FOV: 45 degrees. Color fundus photograph. 1932x1910 — 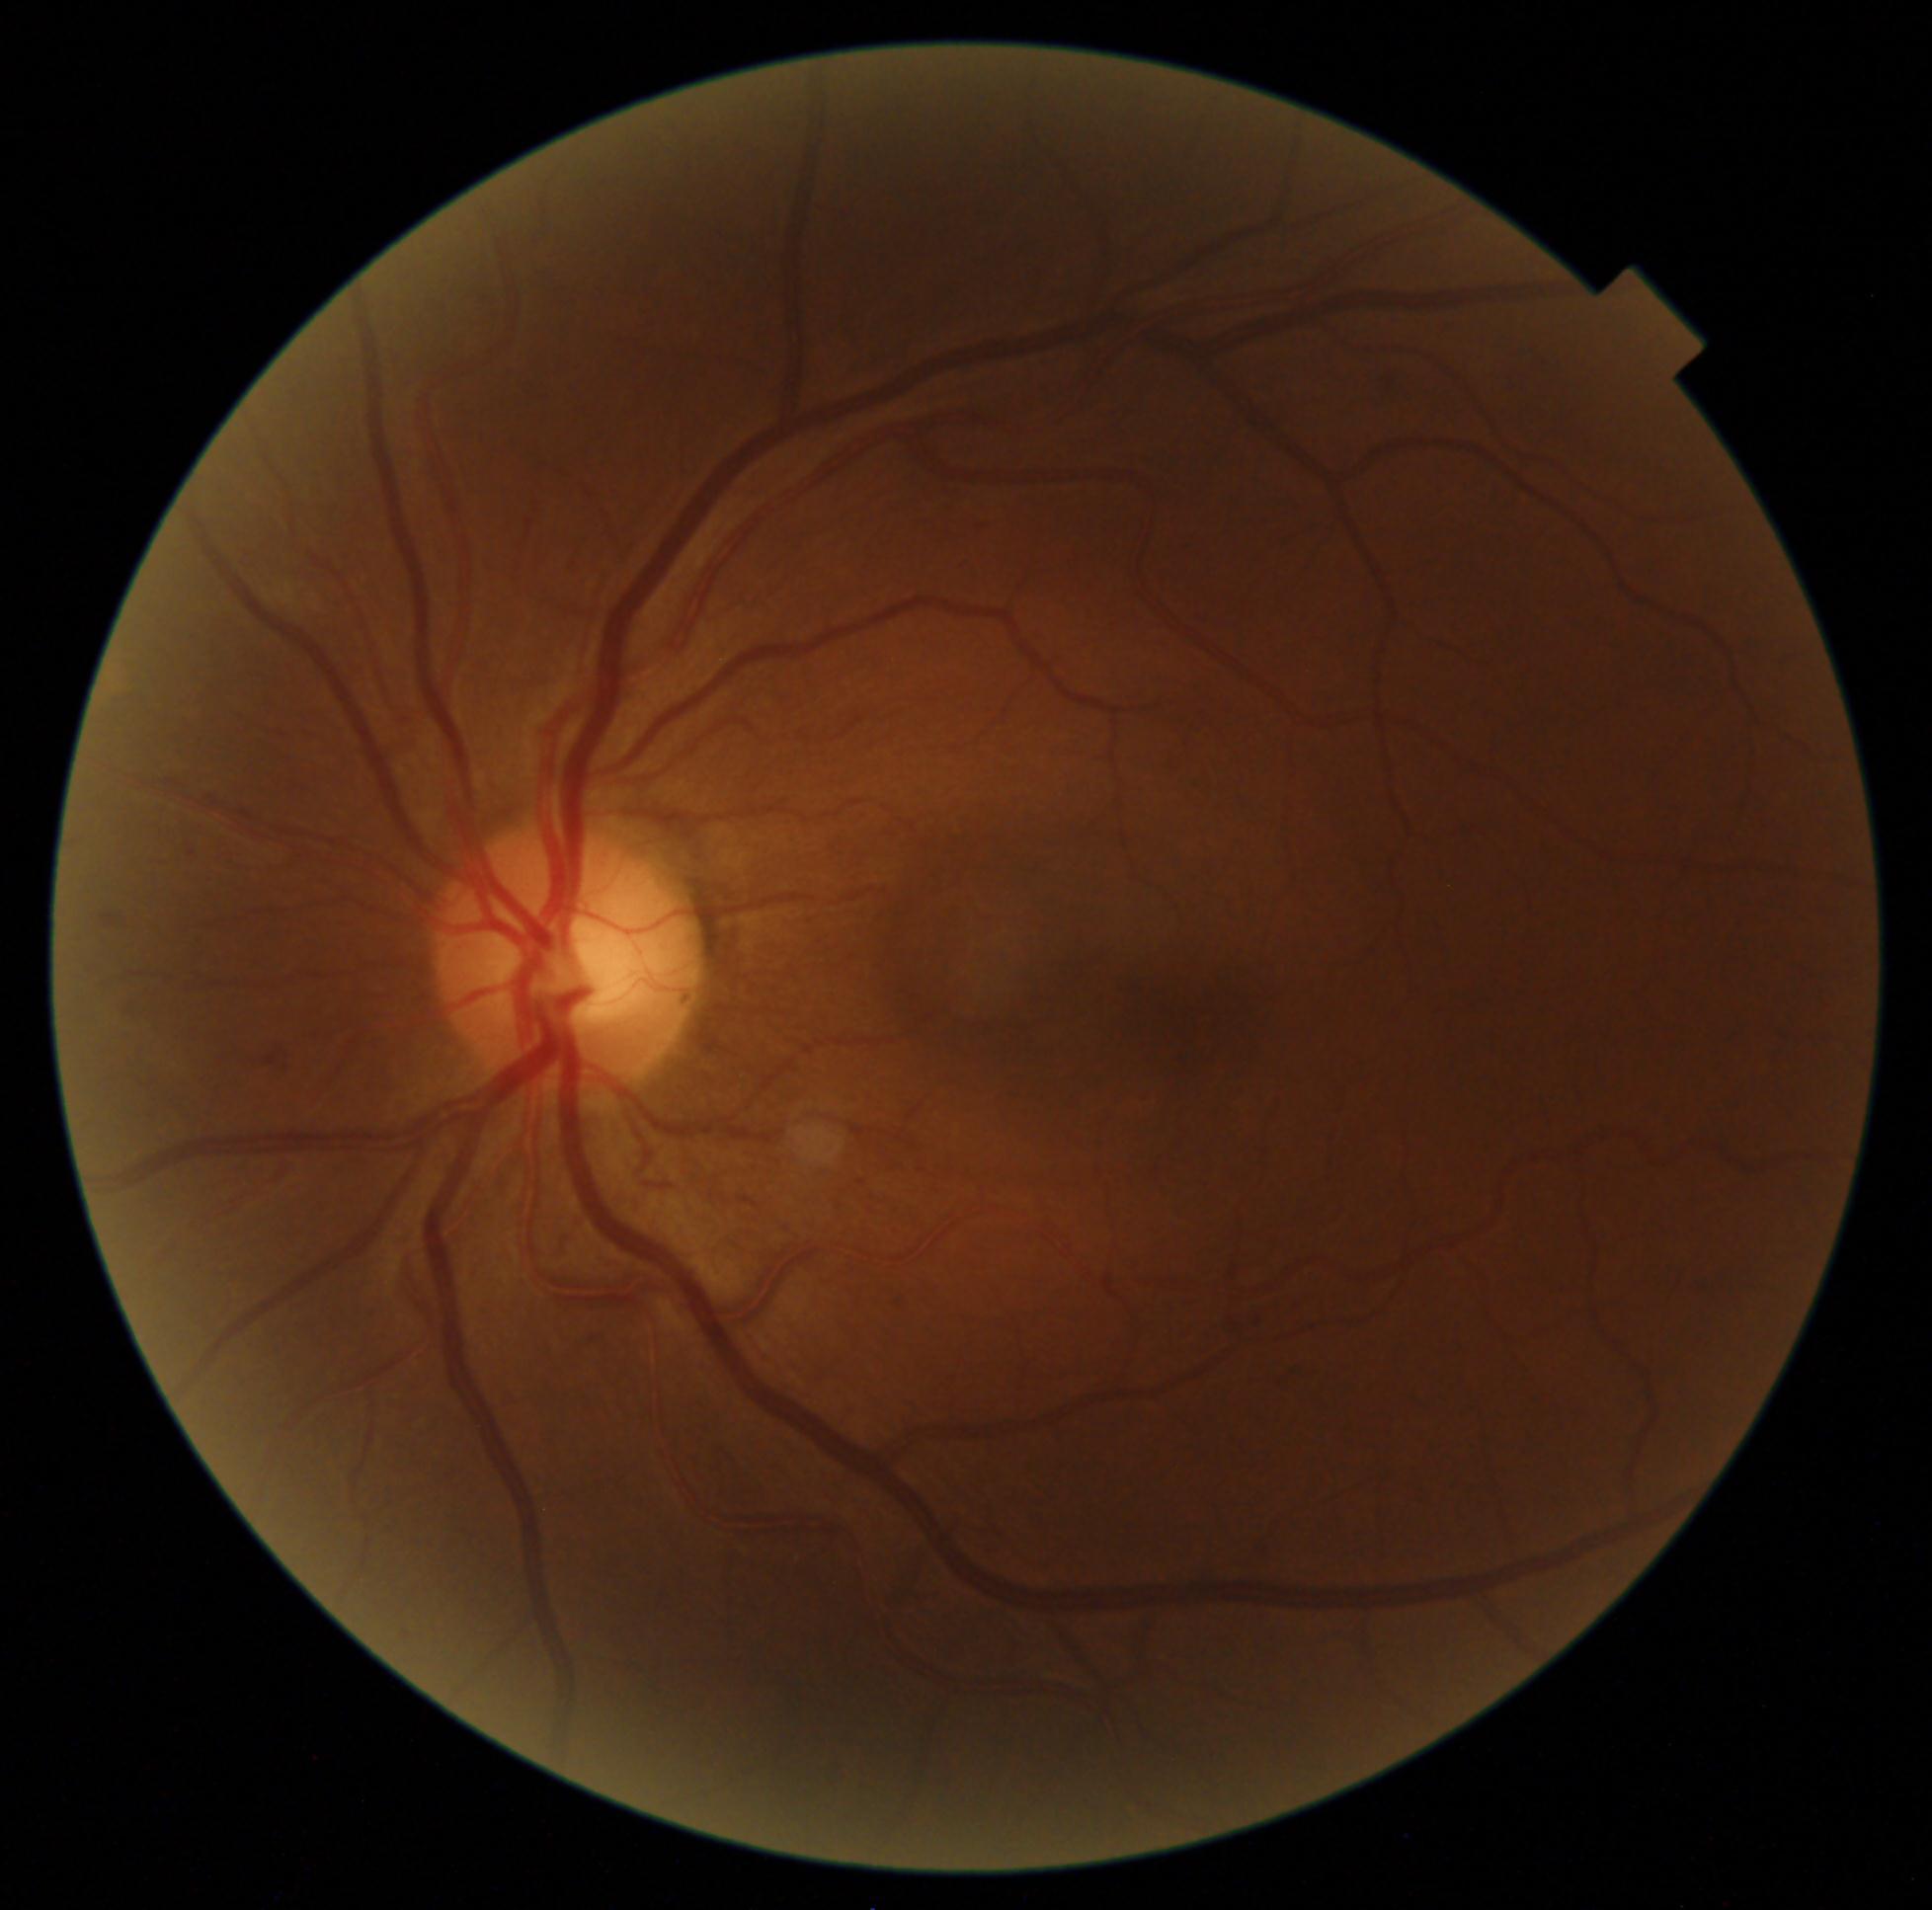 DR severity@moderate non-proliferative diabetic retinopathy (grade 2).